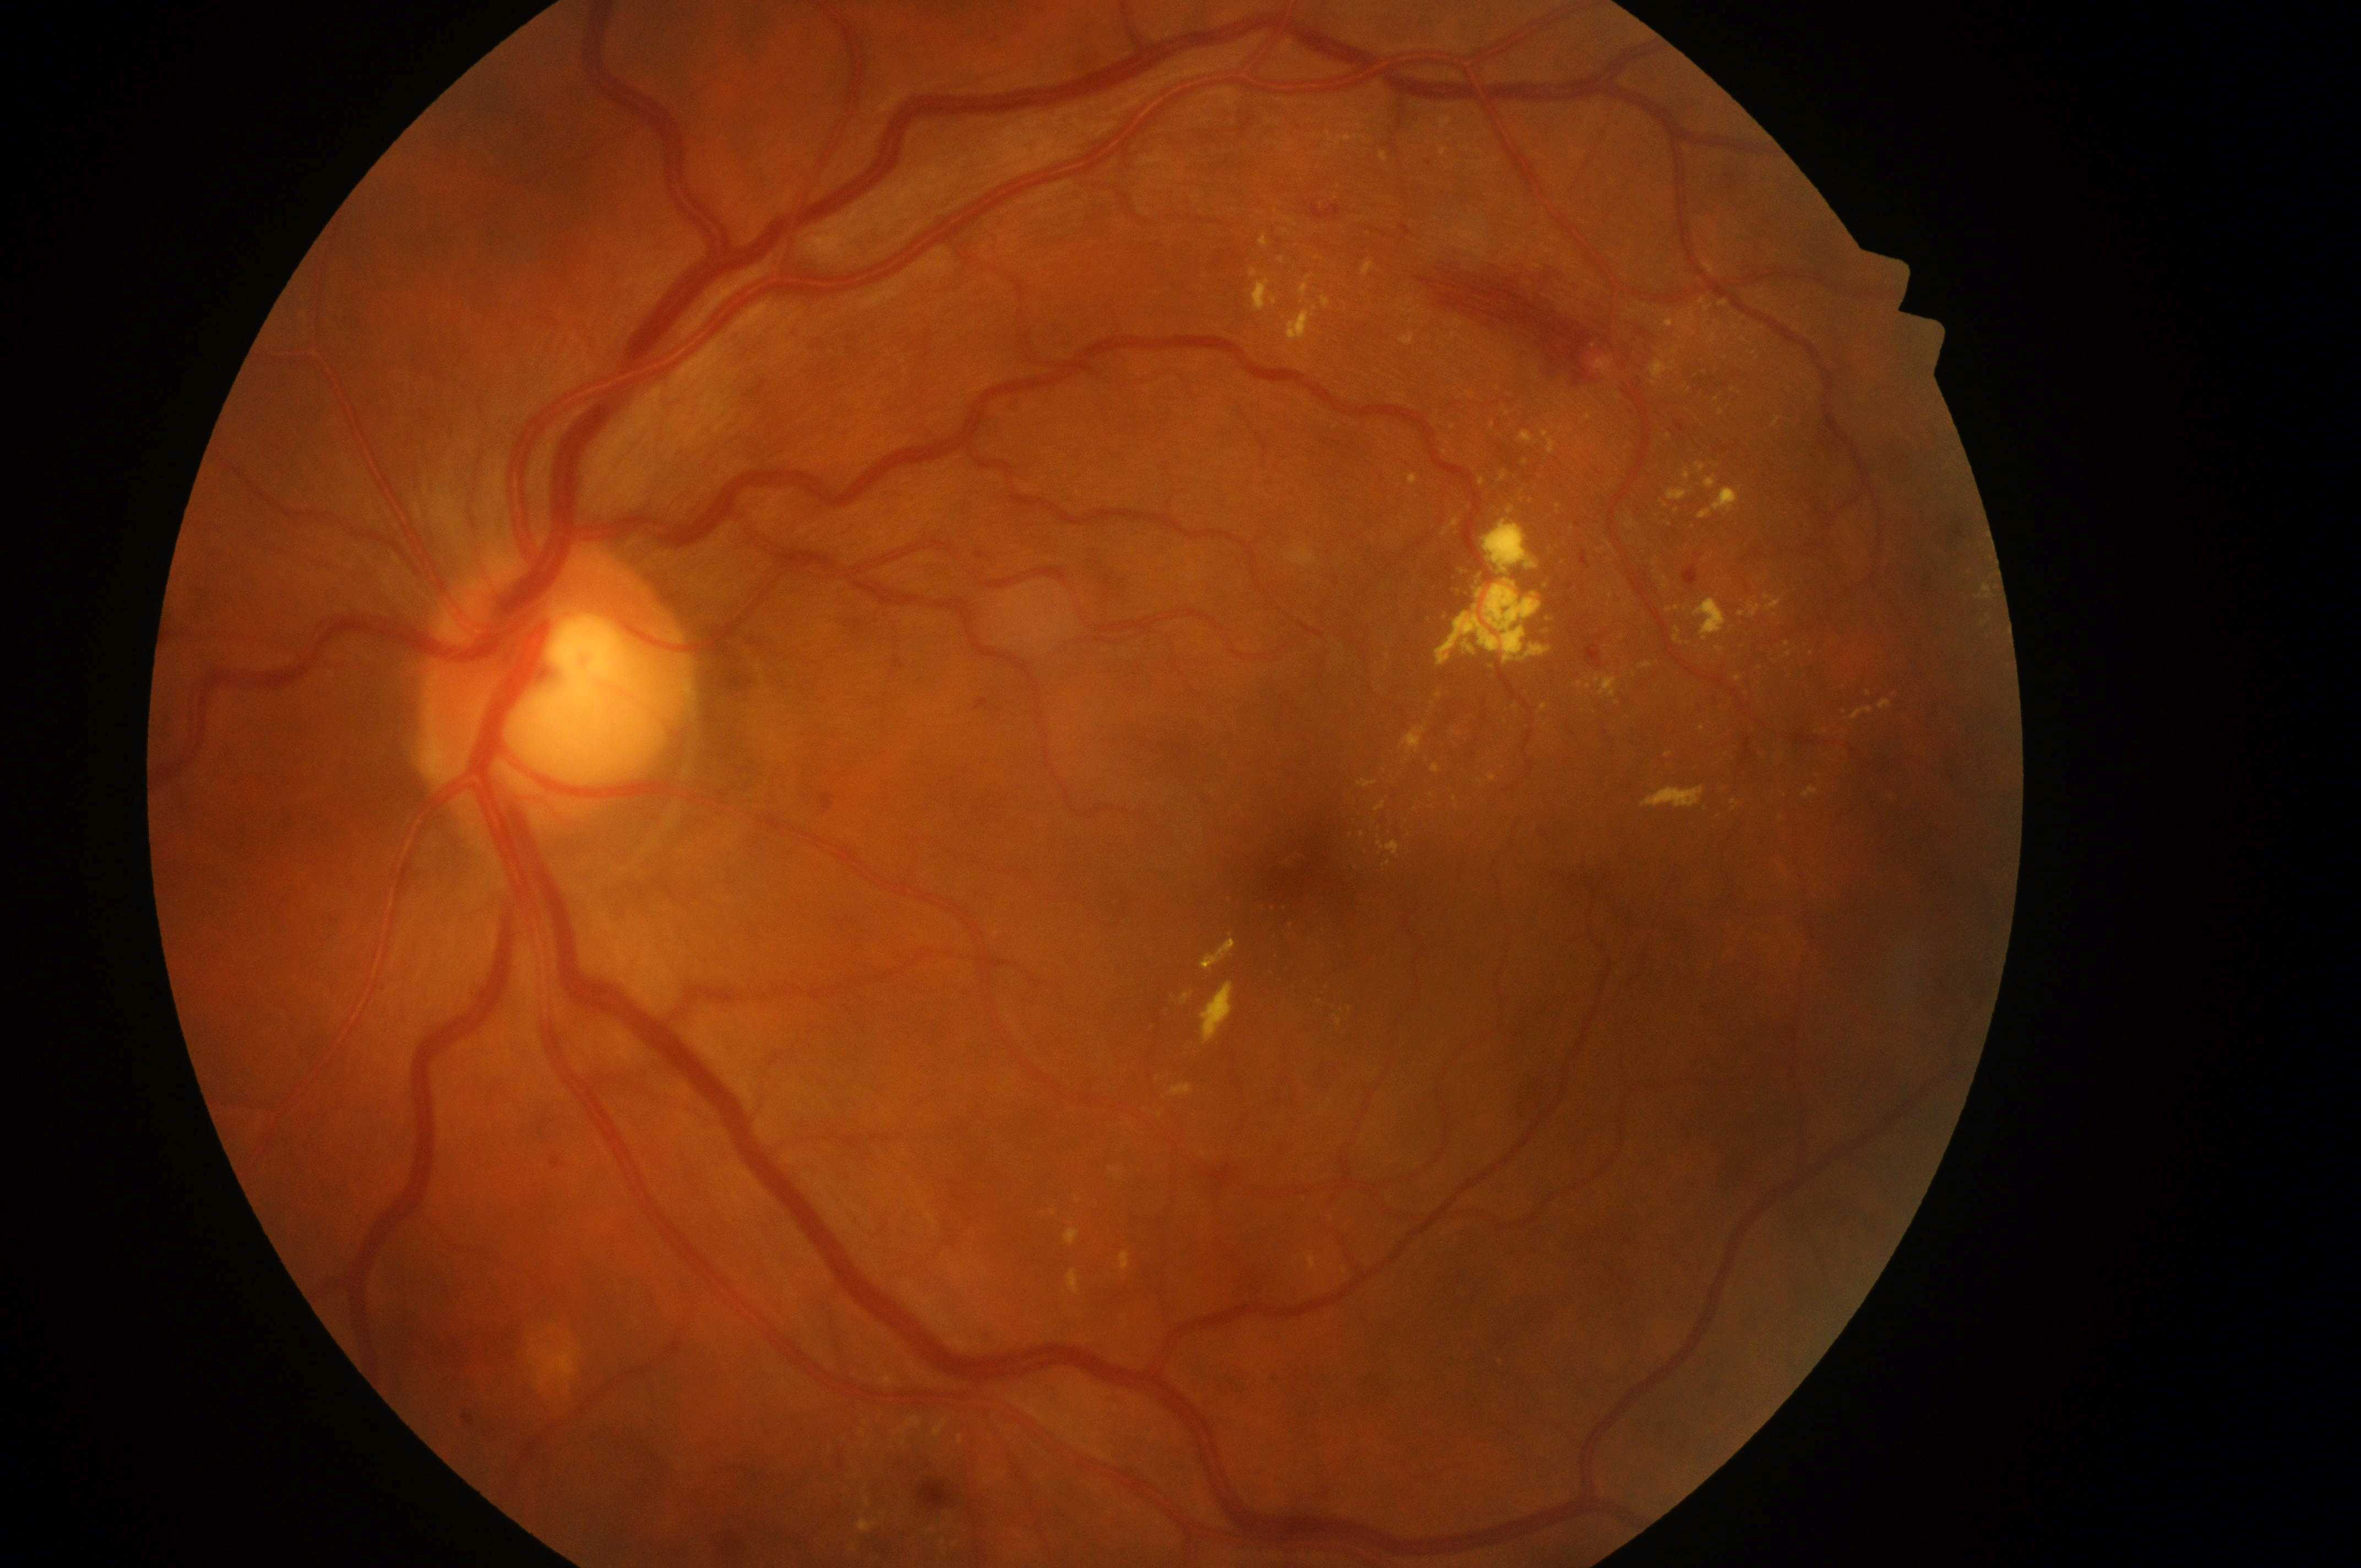
* eye · OS
* risk of diabetic macular edema · high risk (grade 2)
* retinopathy grade · 2 (moderate NPDR)
* macular center · (1312, 868)
* optic disk · (548, 699)